Diabetic retinopathy graded by the modified Davis classification. NIDEK AFC-230. Color fundus image — 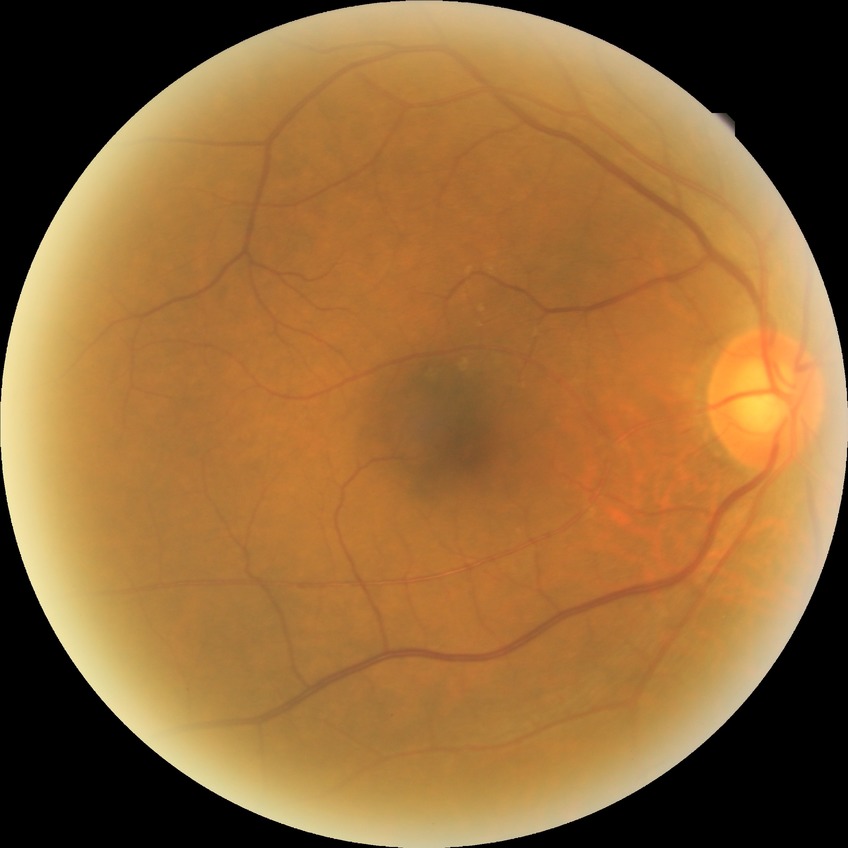

Retinopathy grade is no diabetic retinopathy.